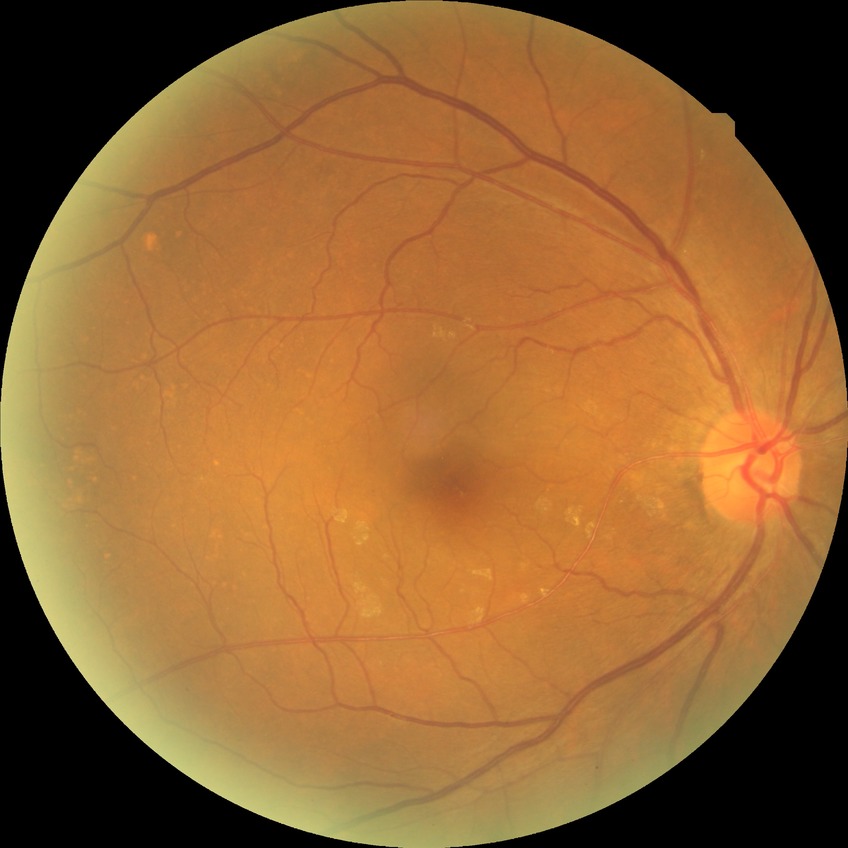

diabetic retinopathy (DR)@NDR (no diabetic retinopathy).